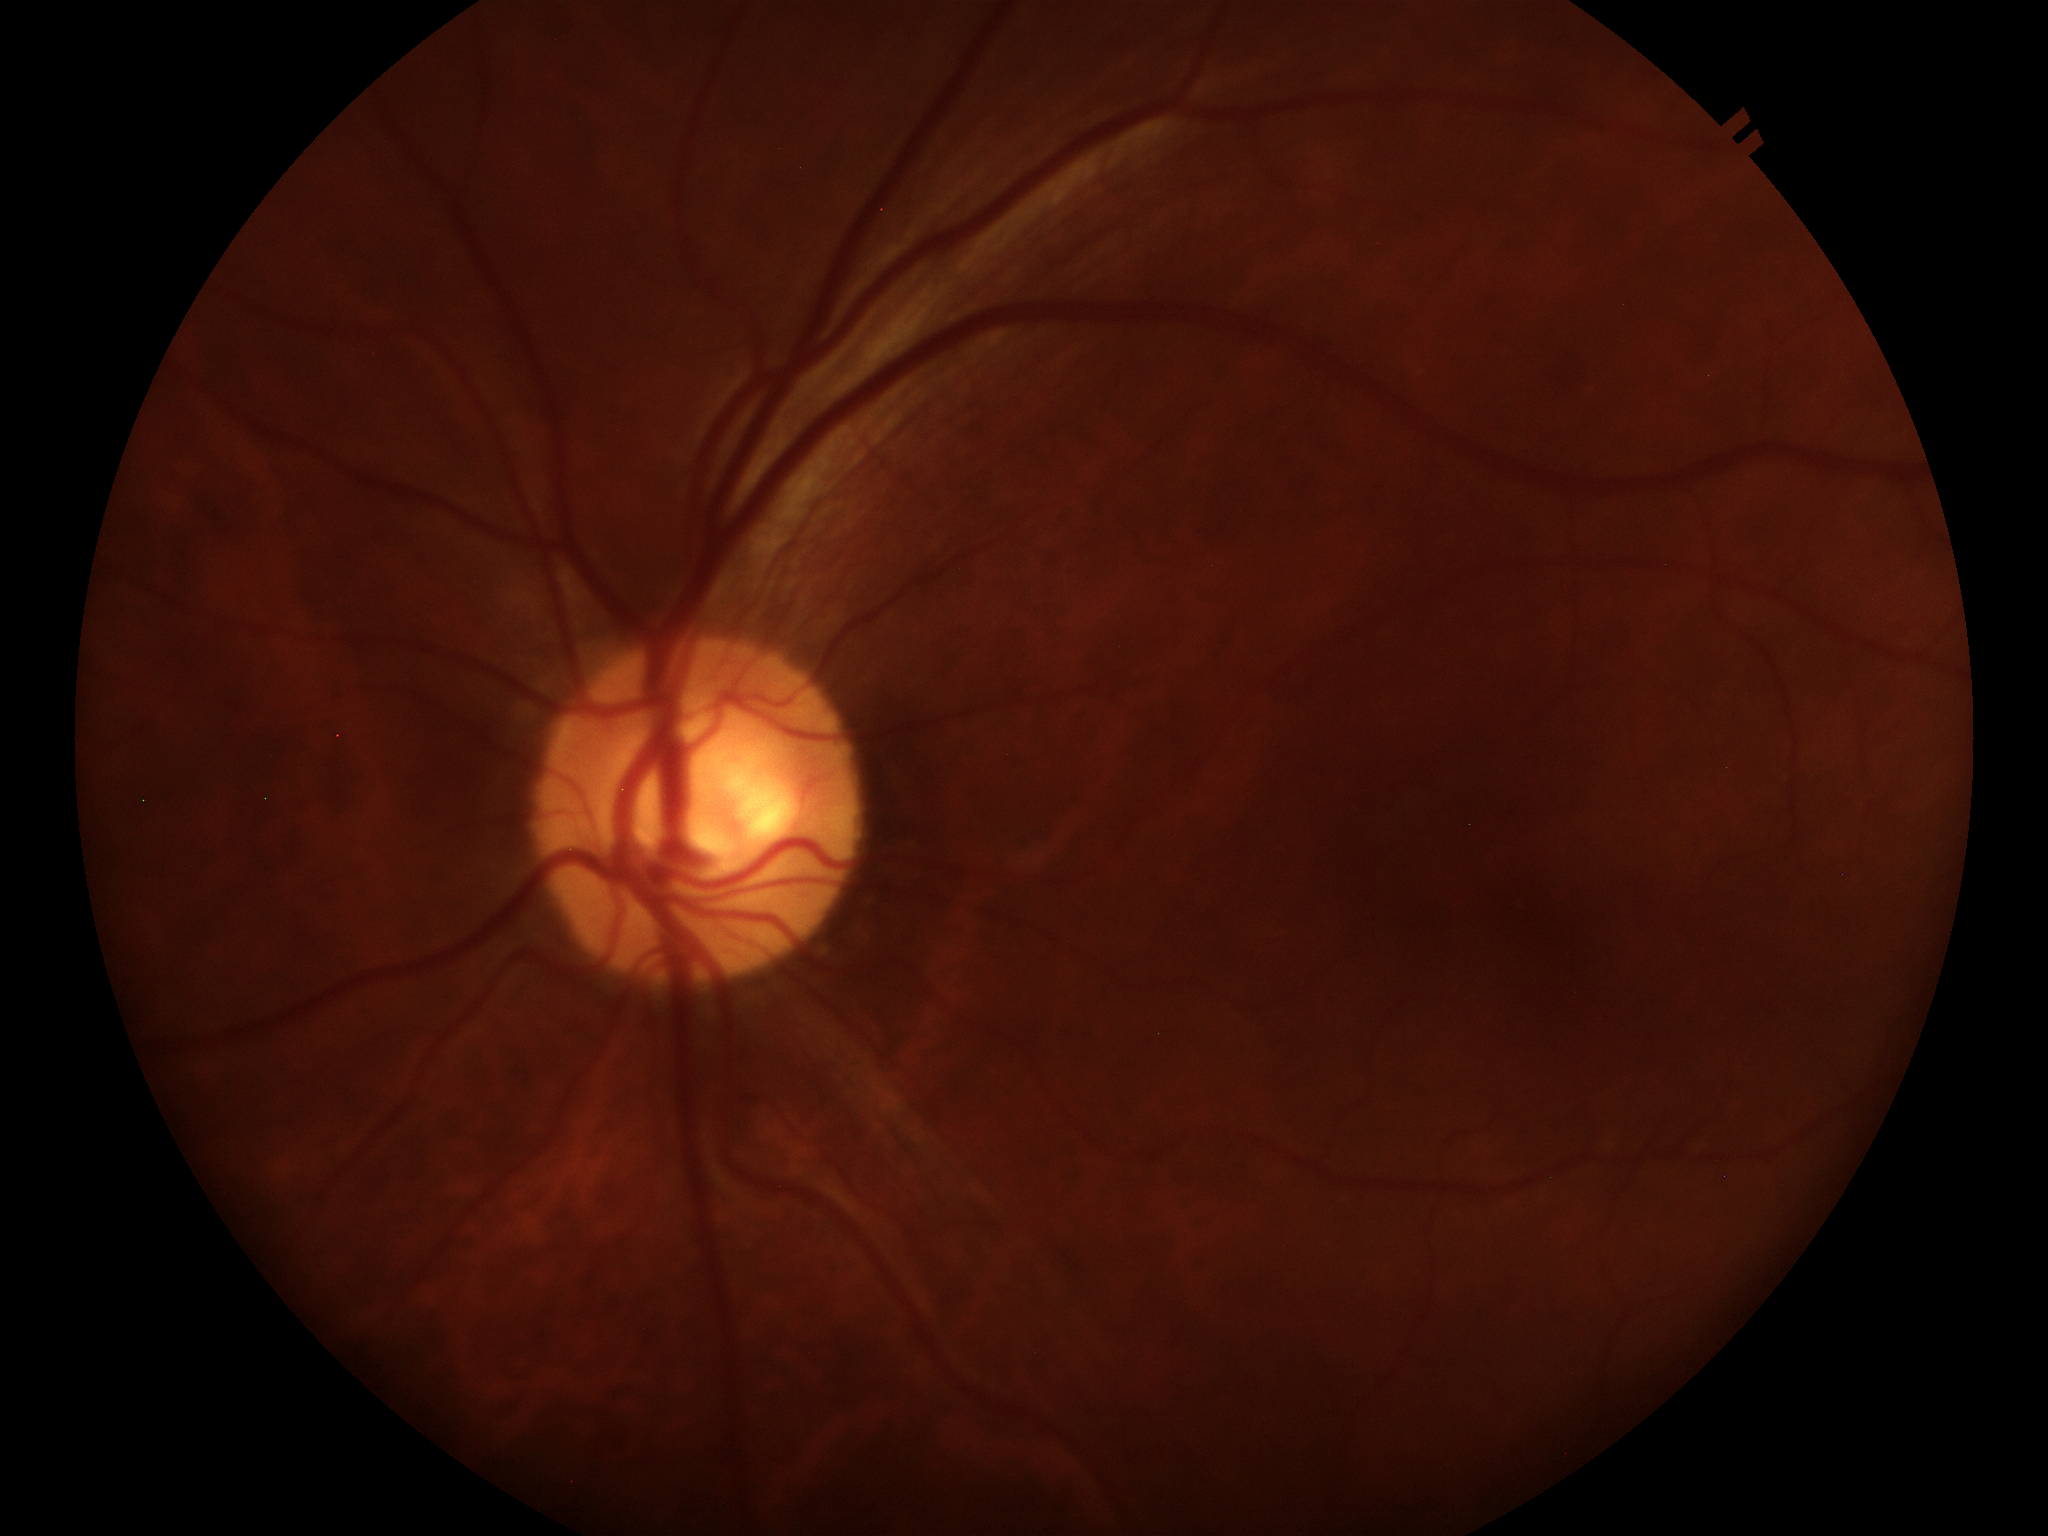 Negative for glaucoma suspicion. Horizontal C/D ratio (HCDR): 0.59. Vertical CDR (VCDR): 0.58. Area CDR (ACDR): 0.34.